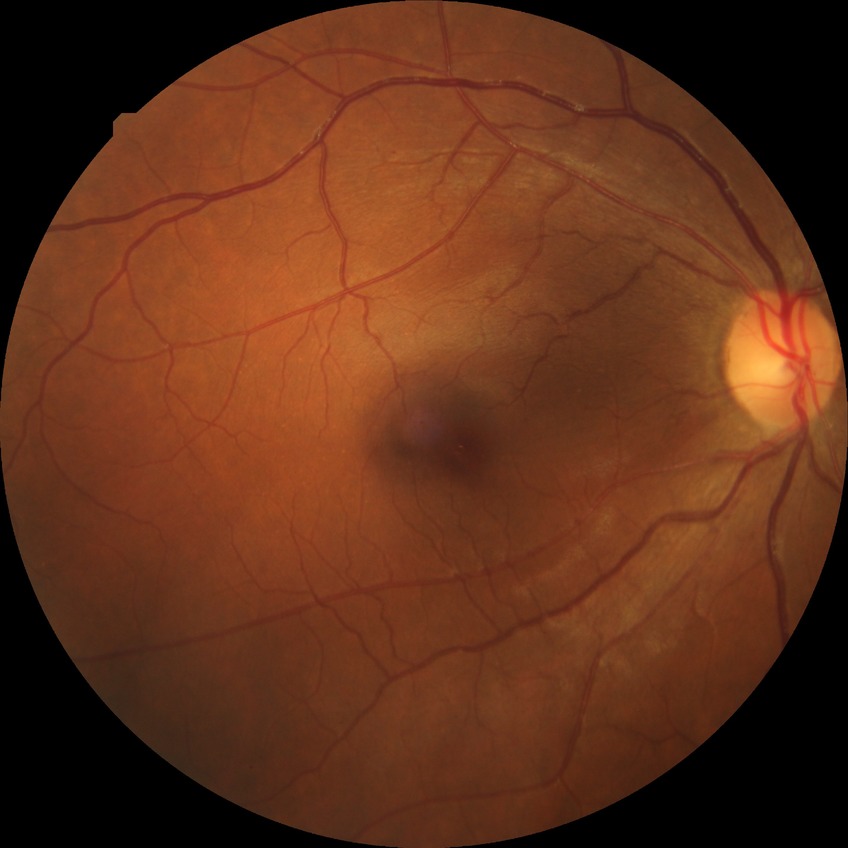
Diabetic retinopathy stage is no diabetic retinopathy.